50-degree field of view, Topcon TRC-NW8, retinal fundus photograph
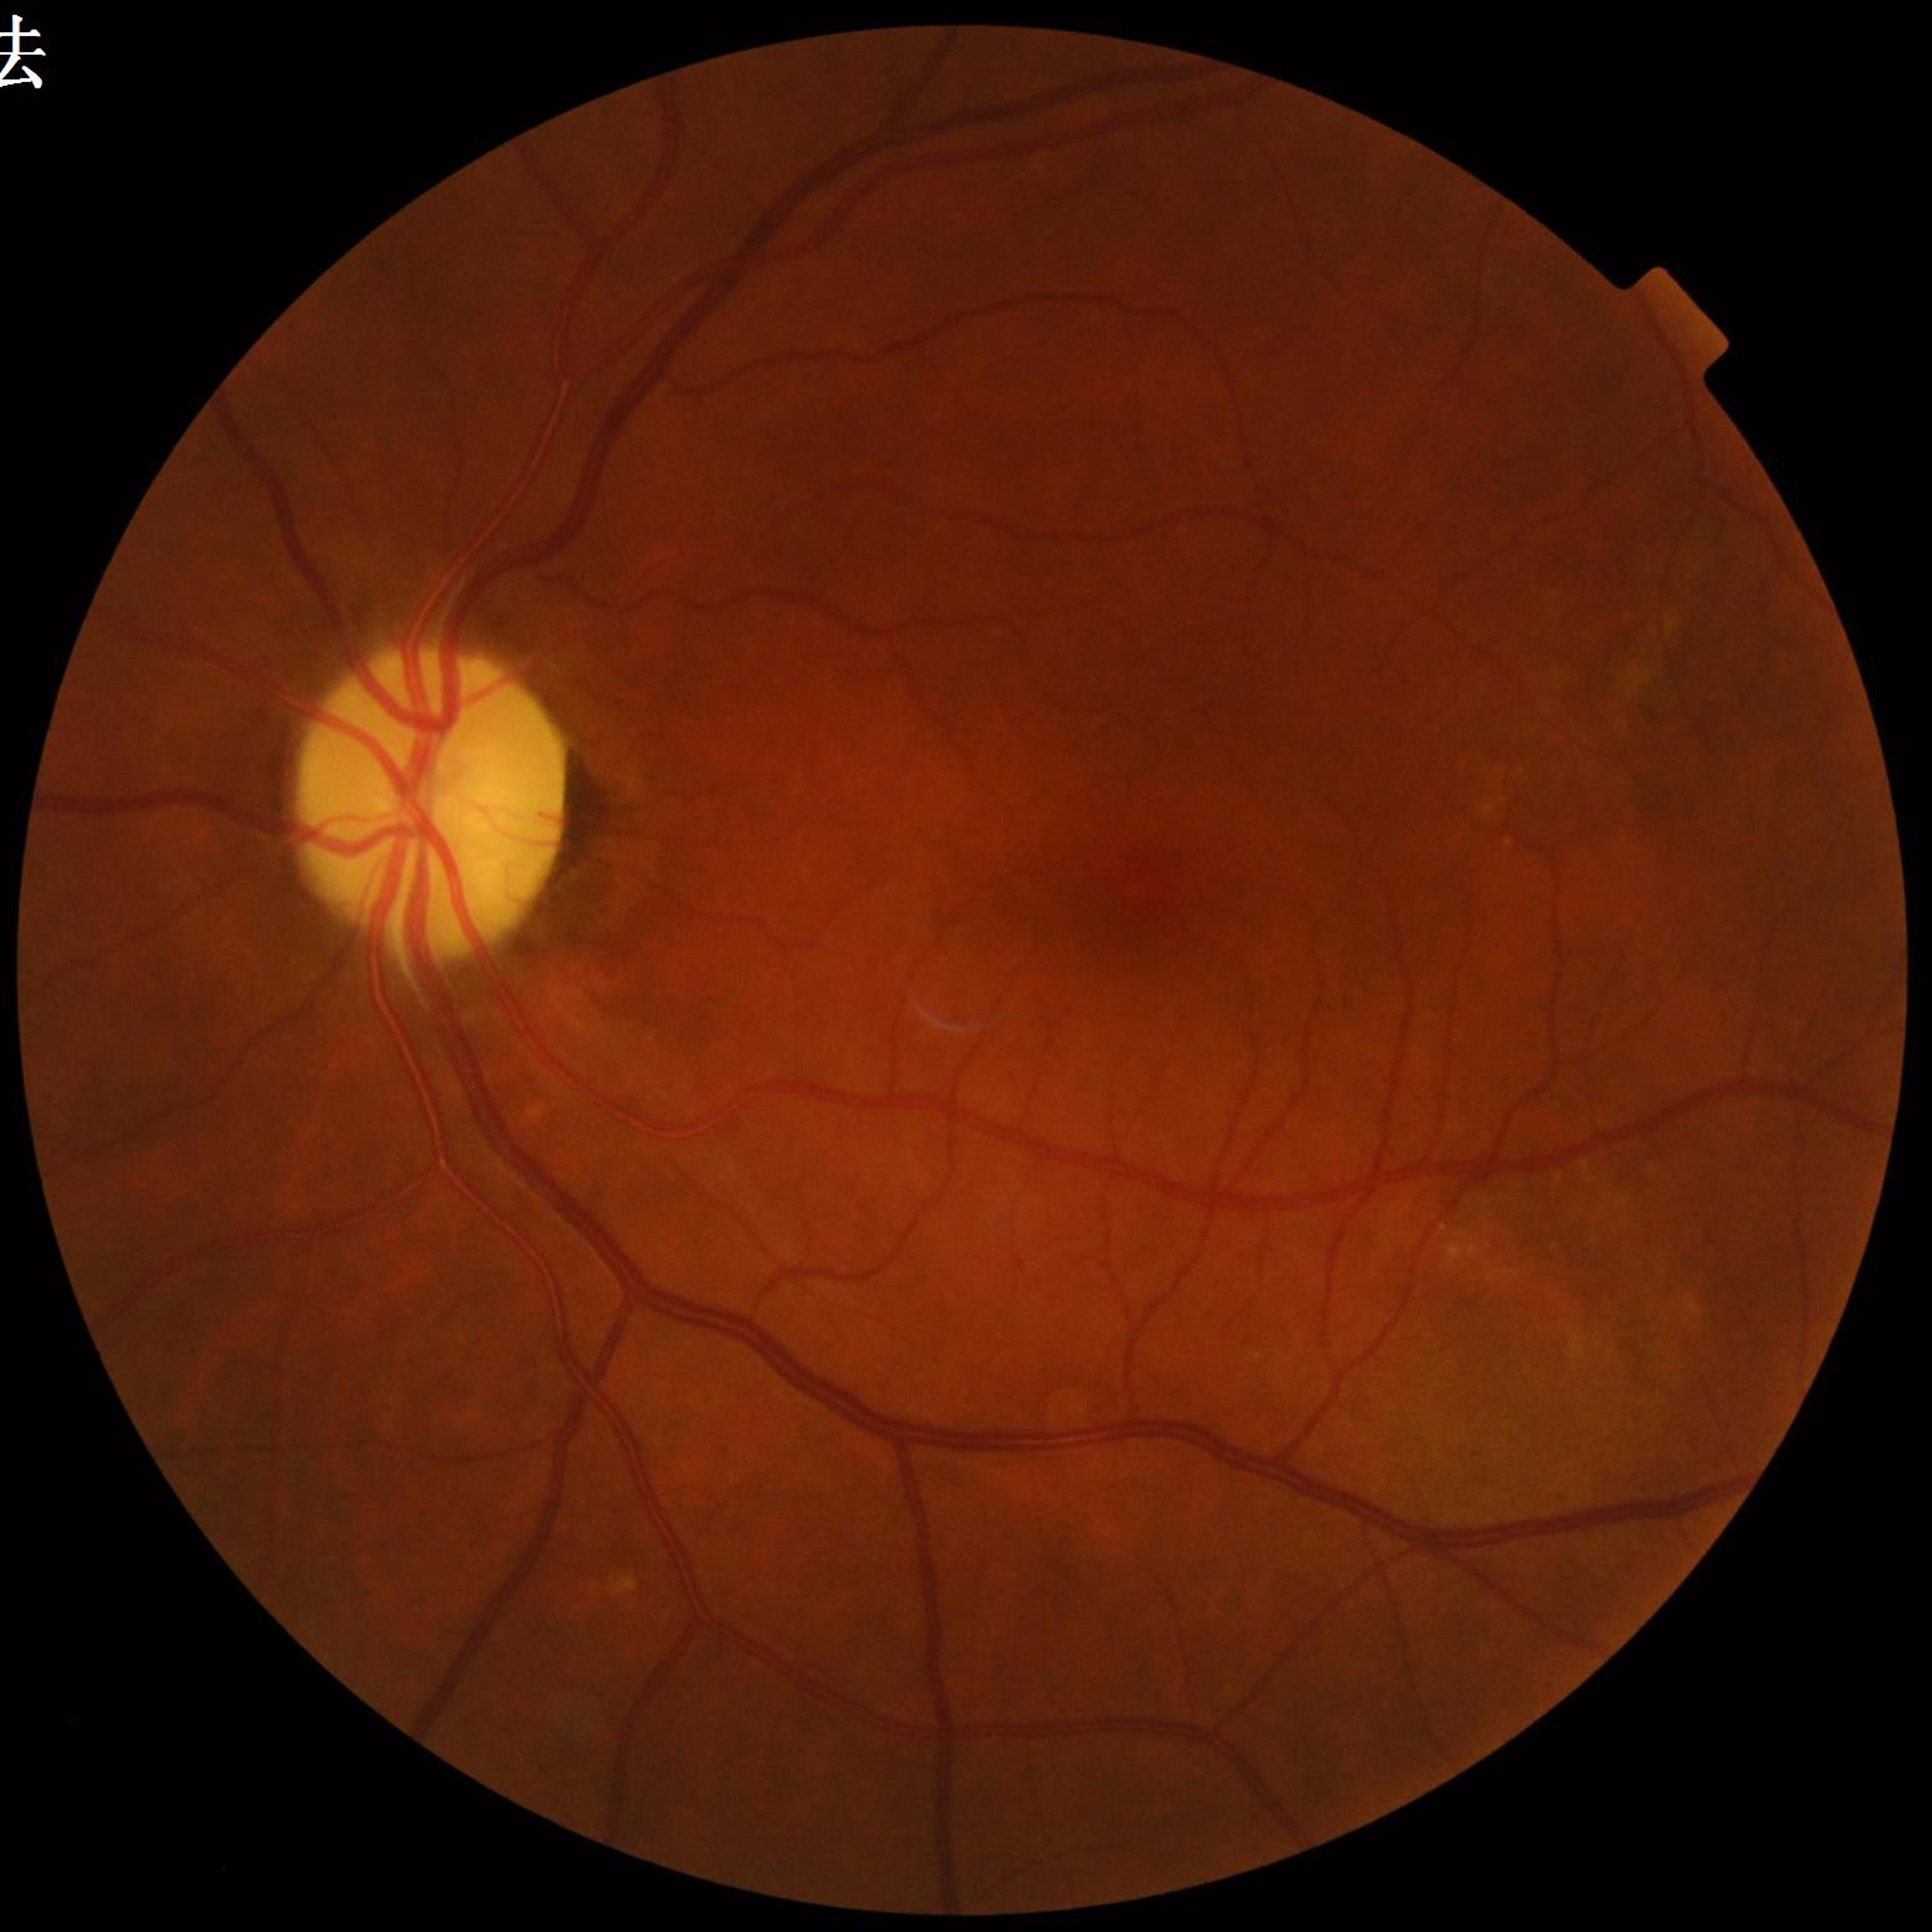 Image quality: good.
Eye affected by diabetic retinopathy.